Image size 2352x1568 — 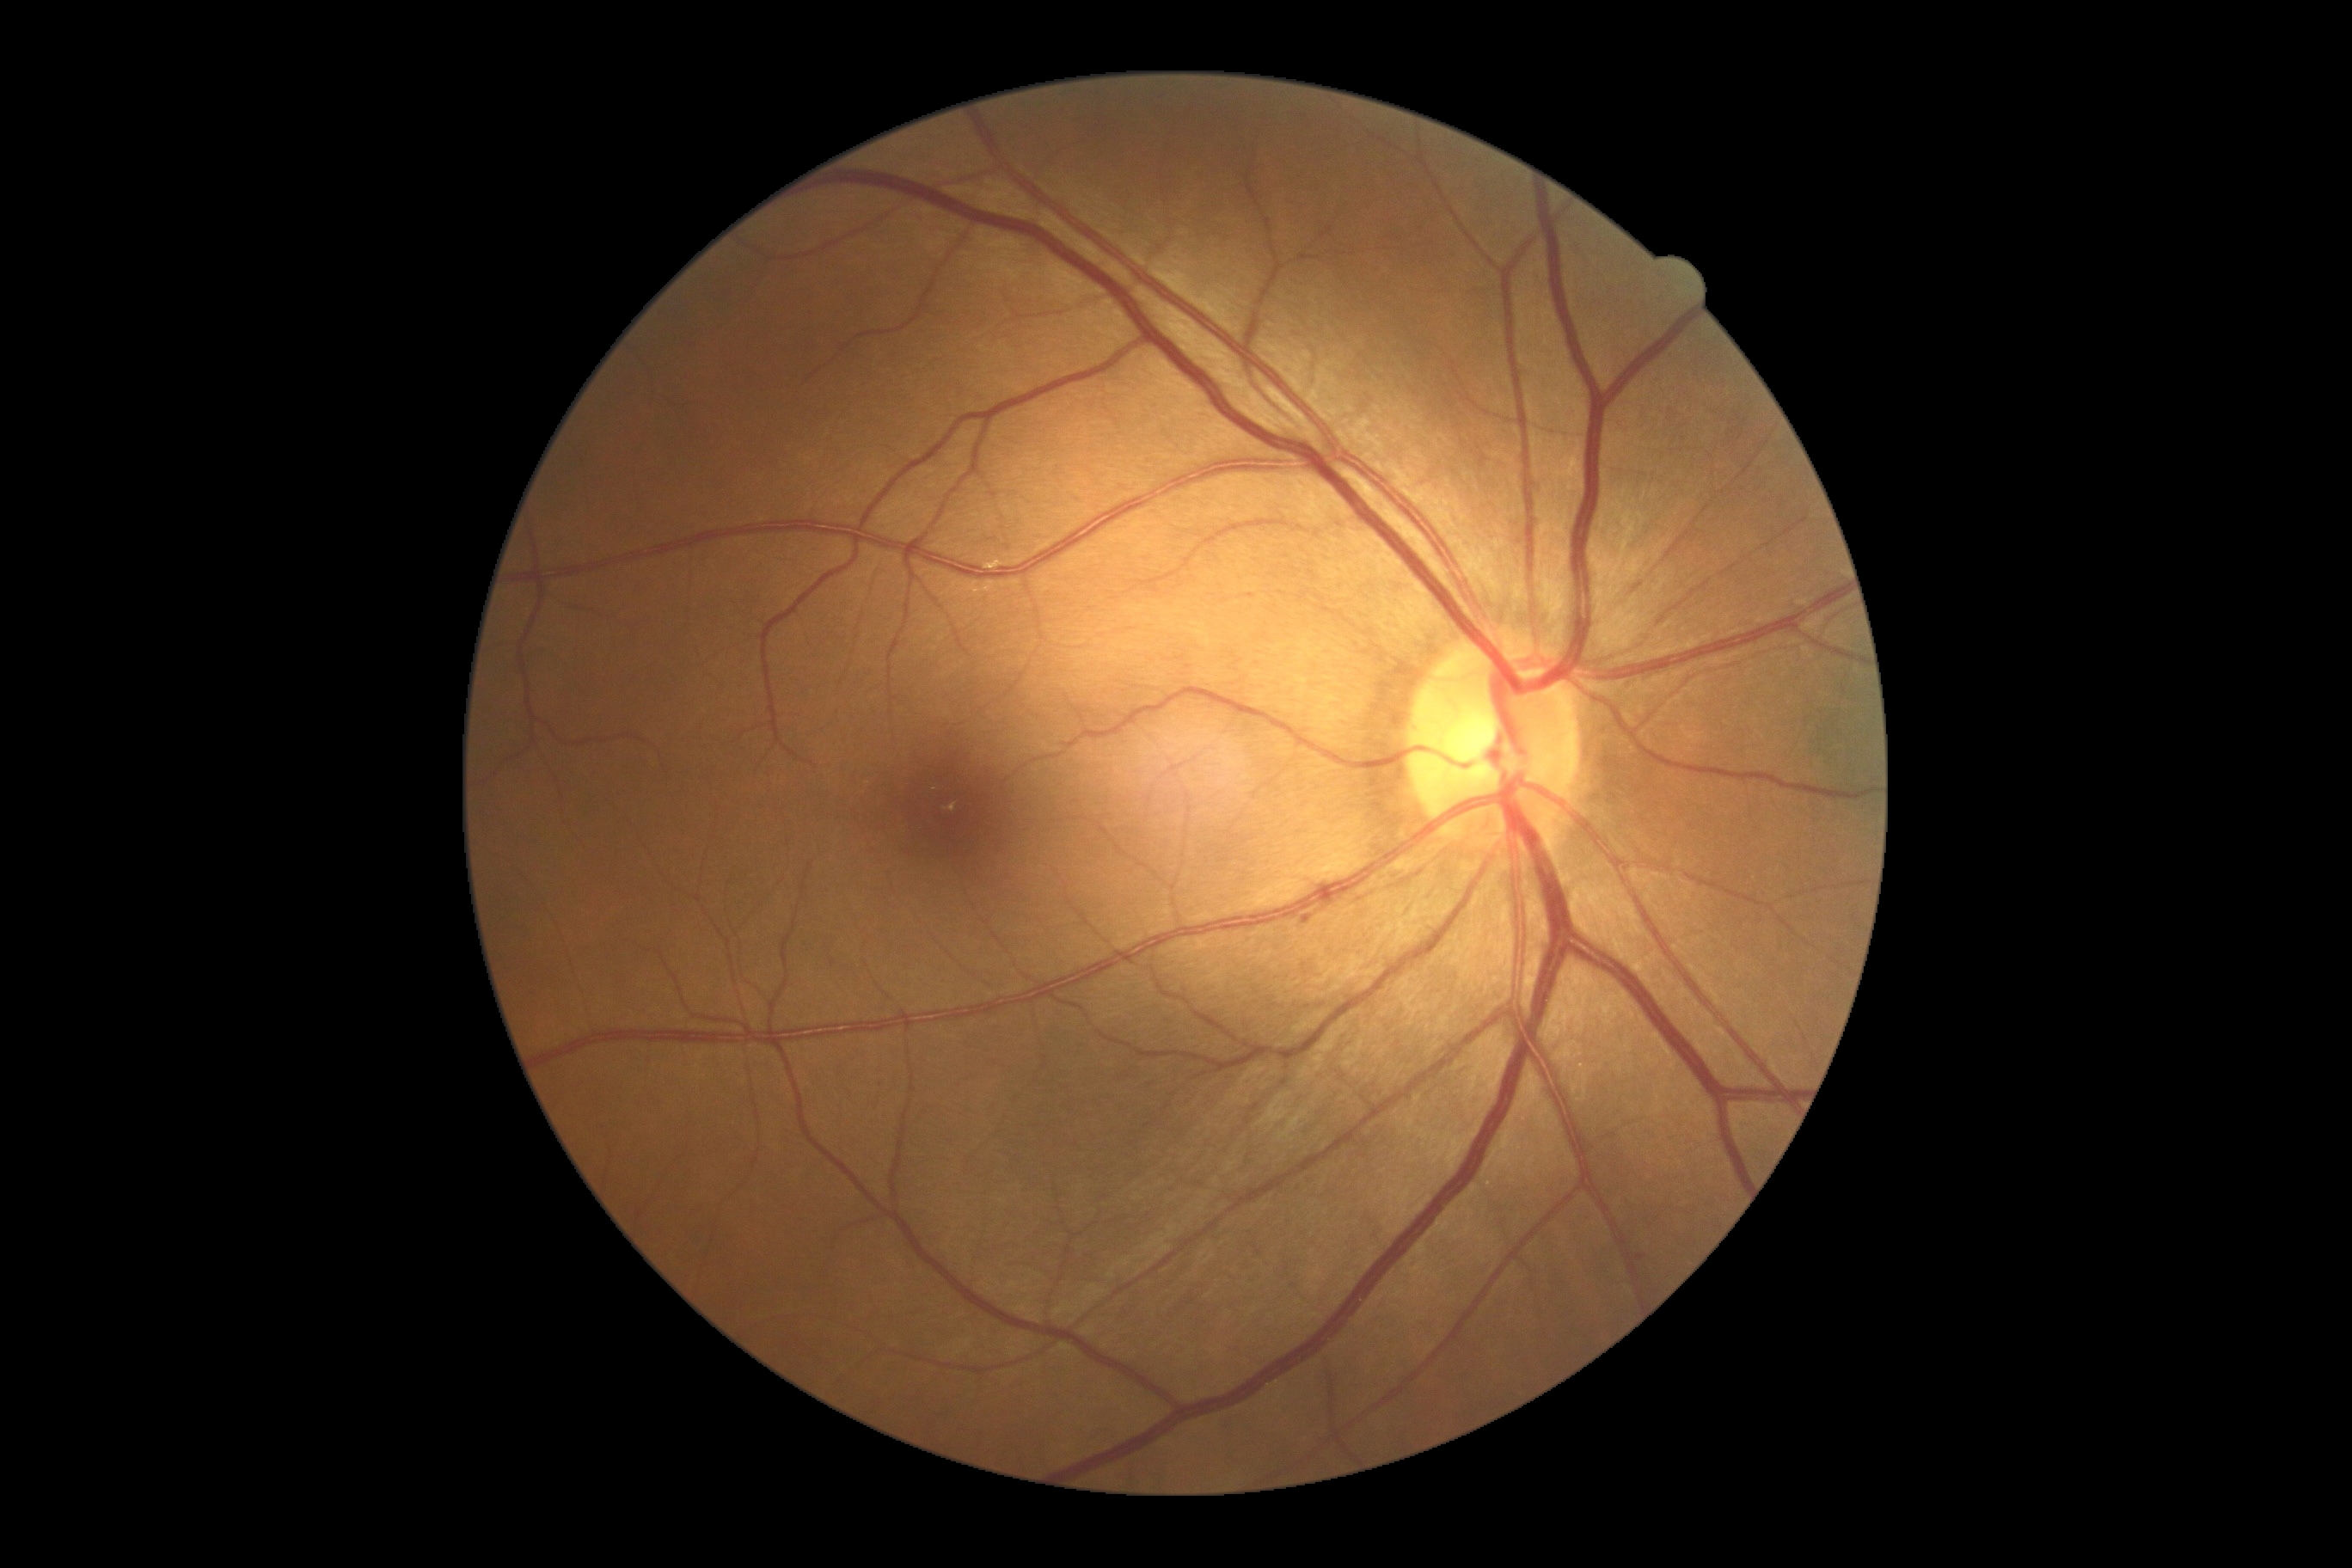
{
  "dr_grade": "2 (moderate NPDR) — more than just microaneurysms but less than severe NPDR"
}